Disc-centered fundus crop.
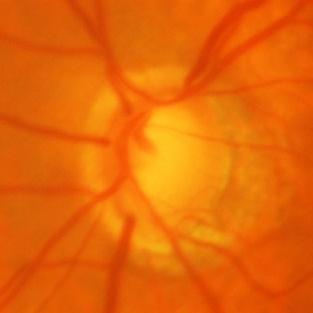
Glaucomatous changes are present. There is evidence of glaucomatous optic neuropathy.